Infant wide-field fundus photograph.
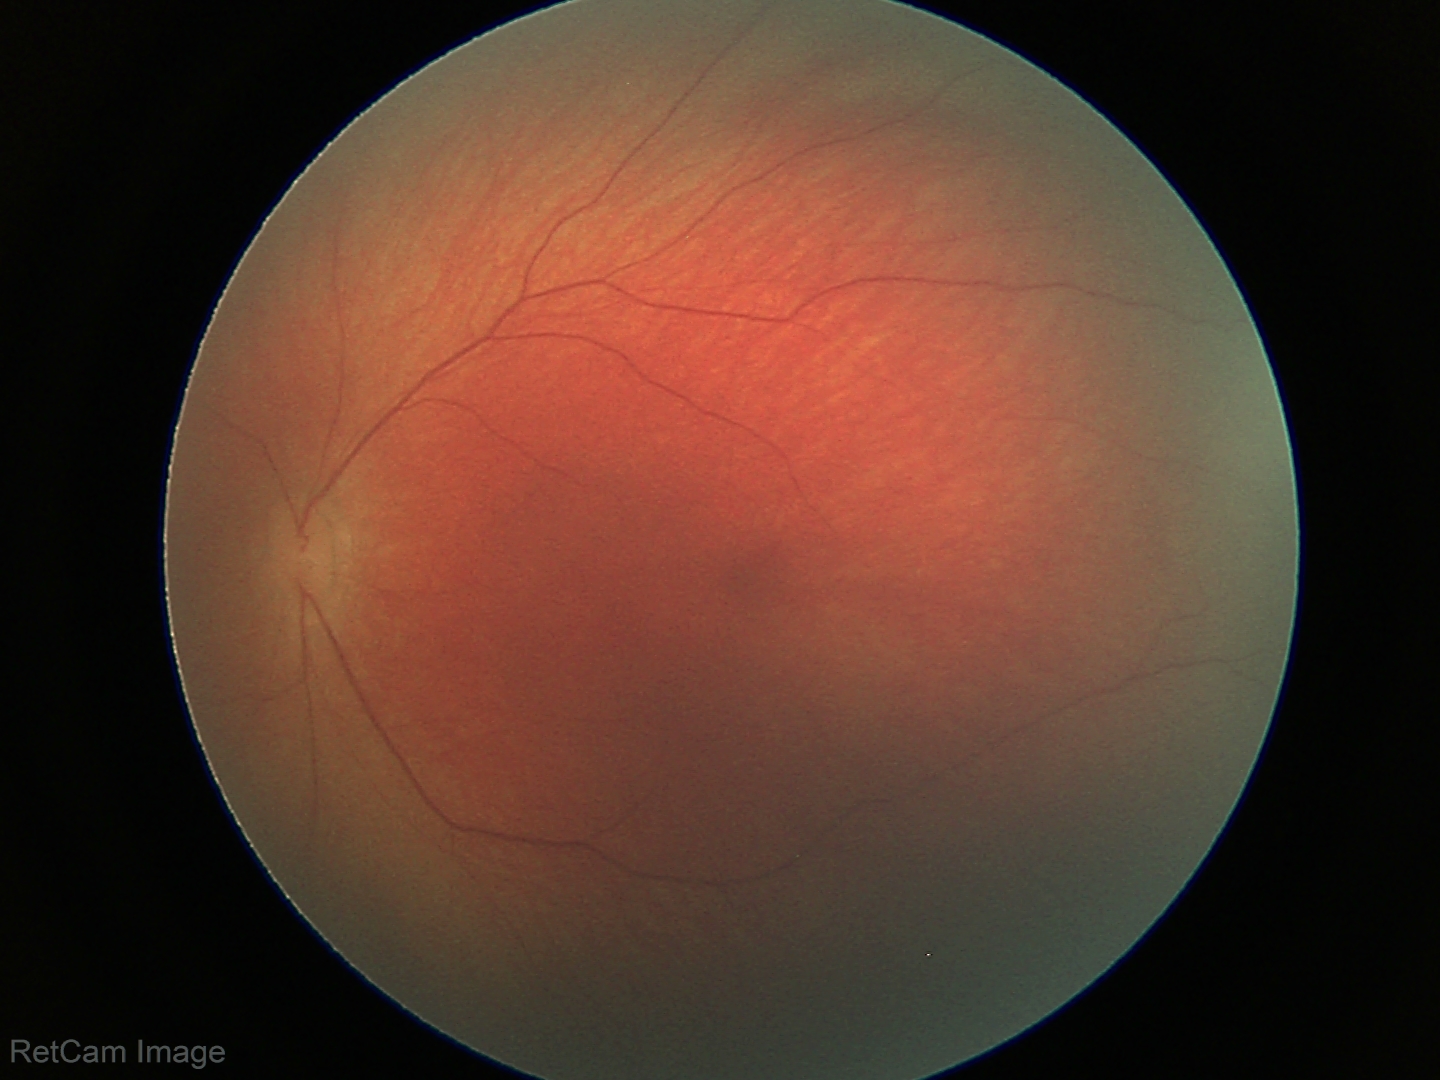

Screening diagnosis = no pathology identified.